Wide-field fundus image from infant ROP screening.
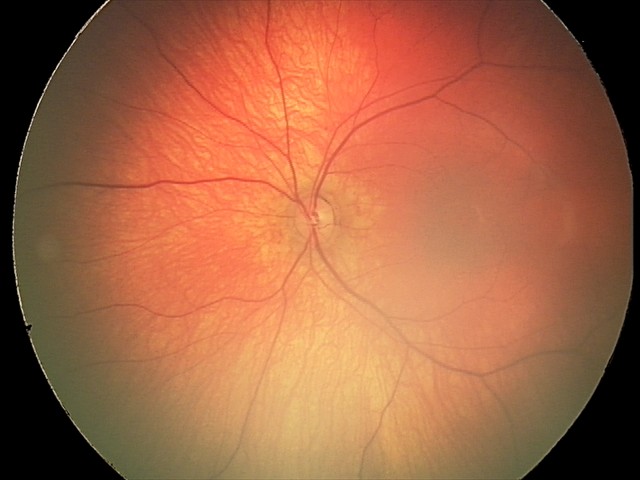
Screening examination diagnosed as physiological.